2212x1659px, handheld portable fundus camera image — 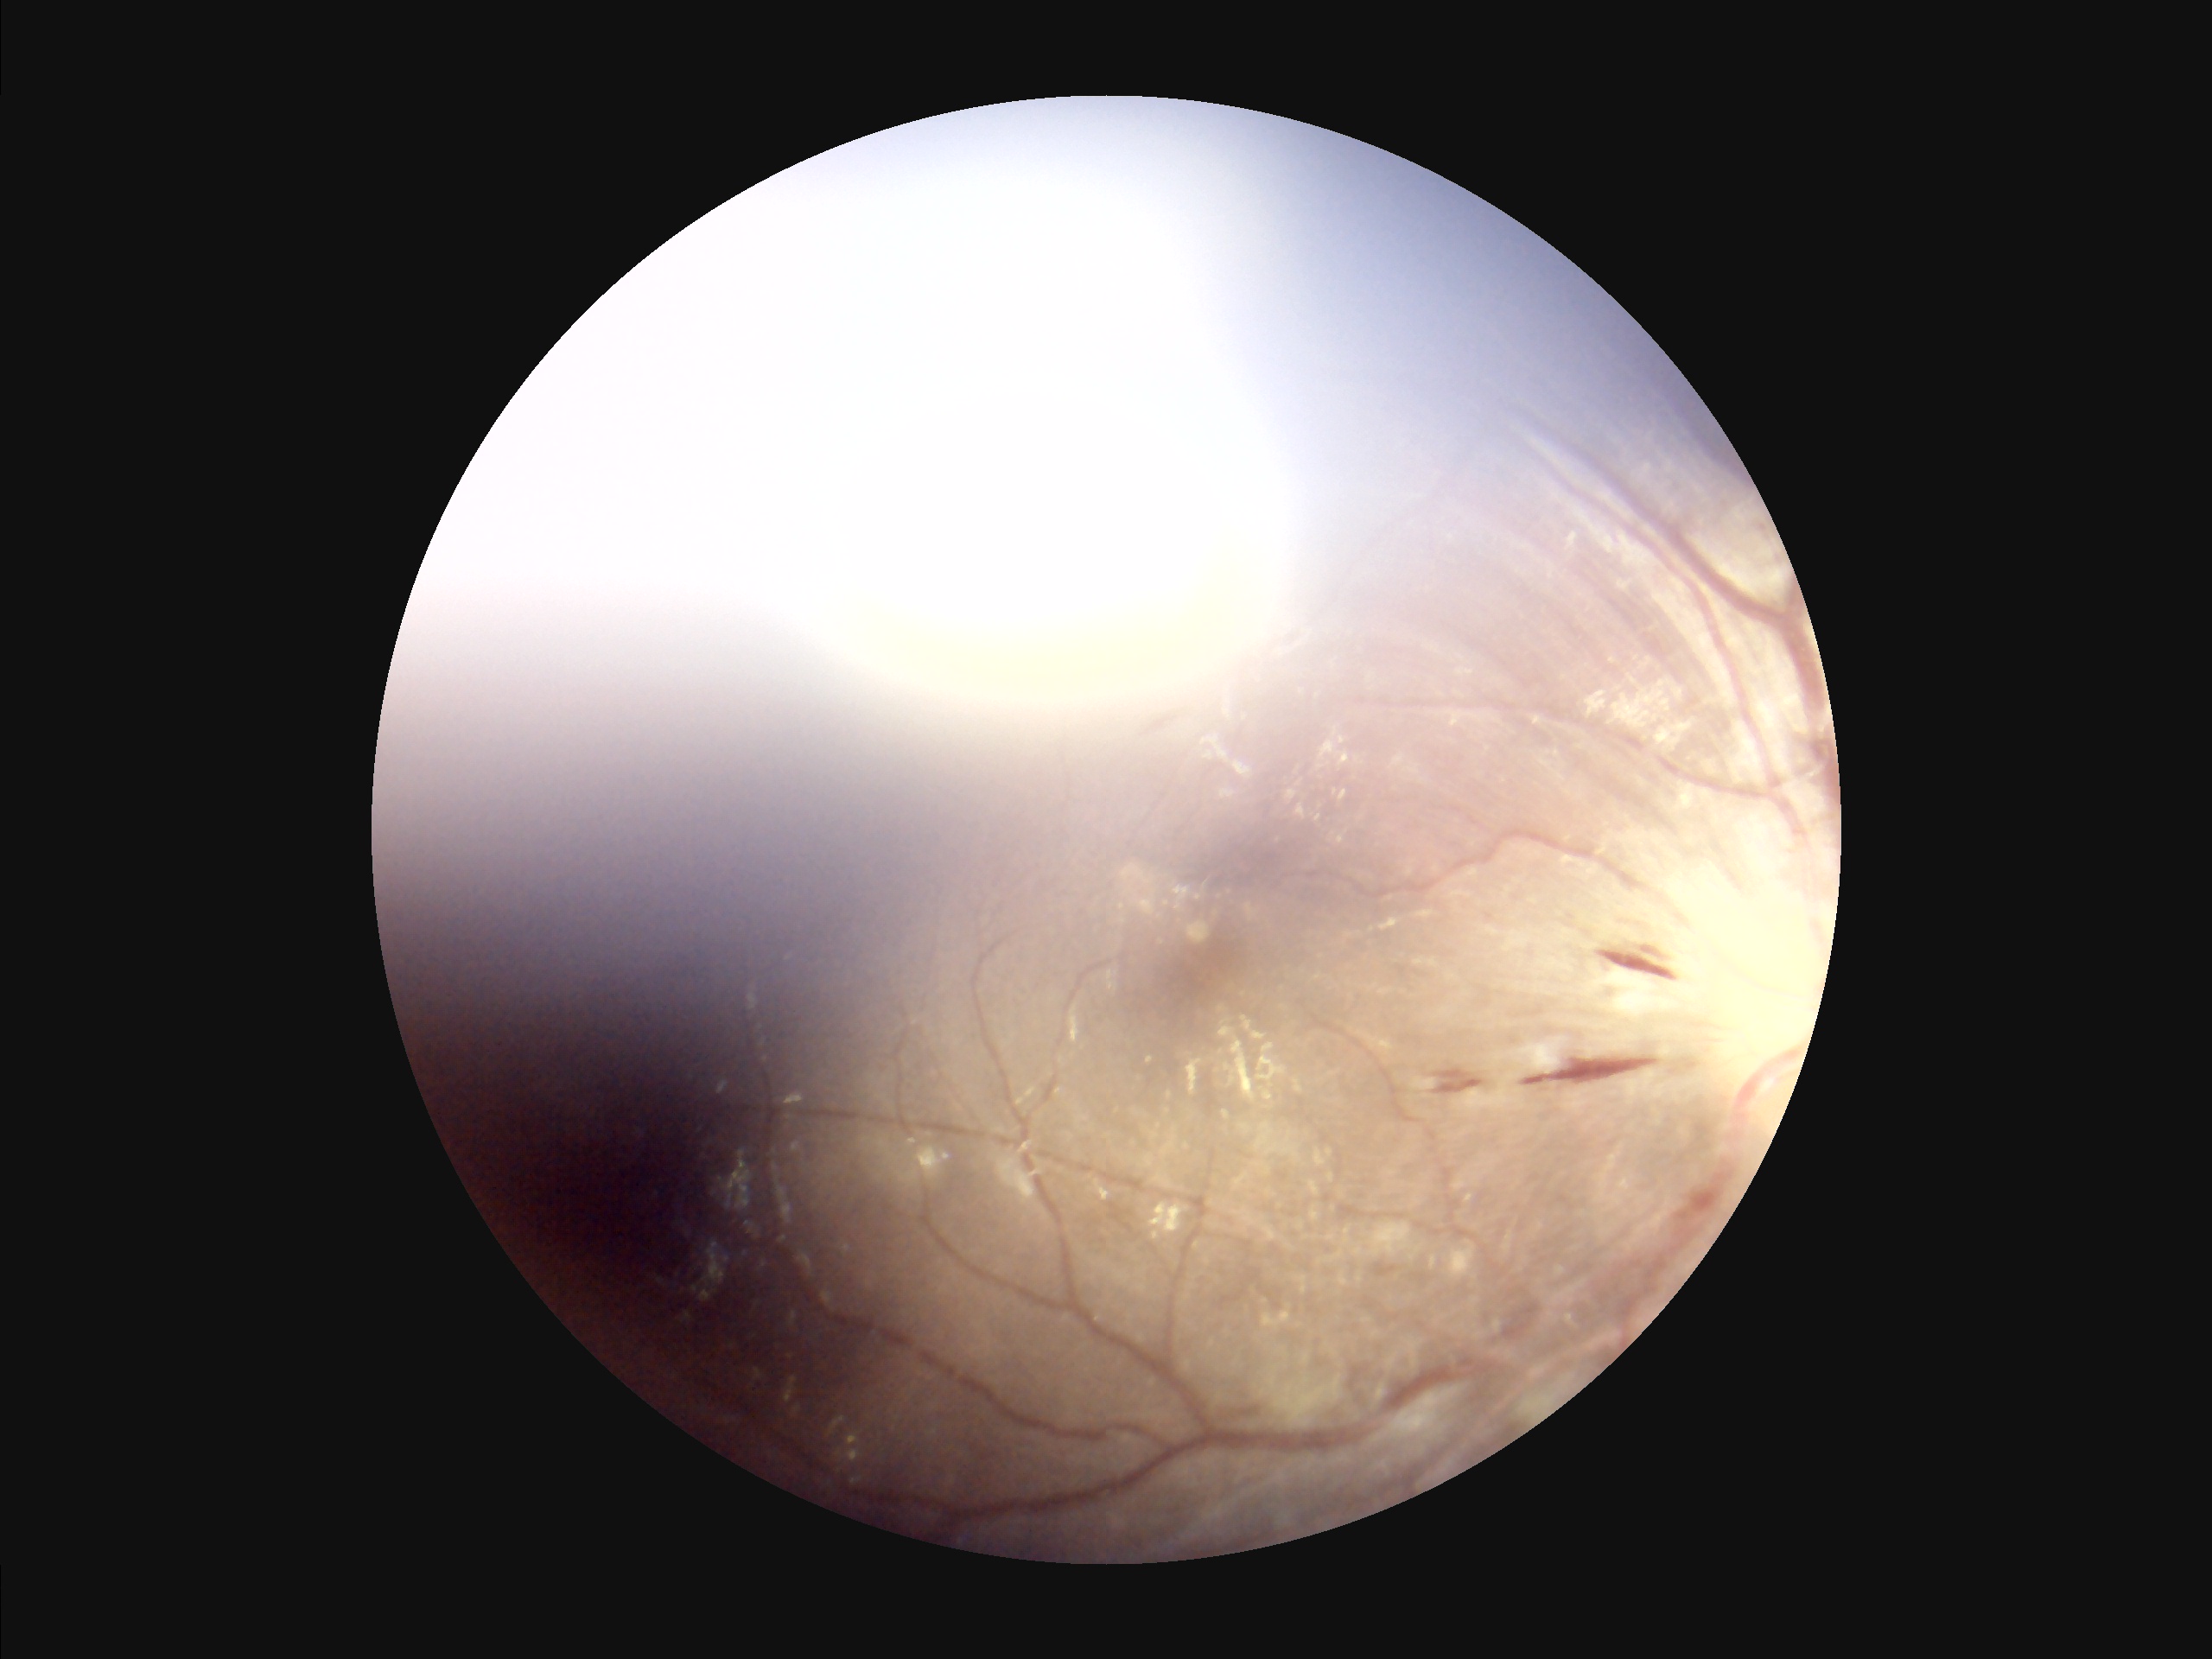 Image quality assessment: contrast: reduced | clarity: reduced | overall: low | illumination: poor.